RetCam wide-field infant fundus image; camera: Natus RetCam Envision (130° FOV)
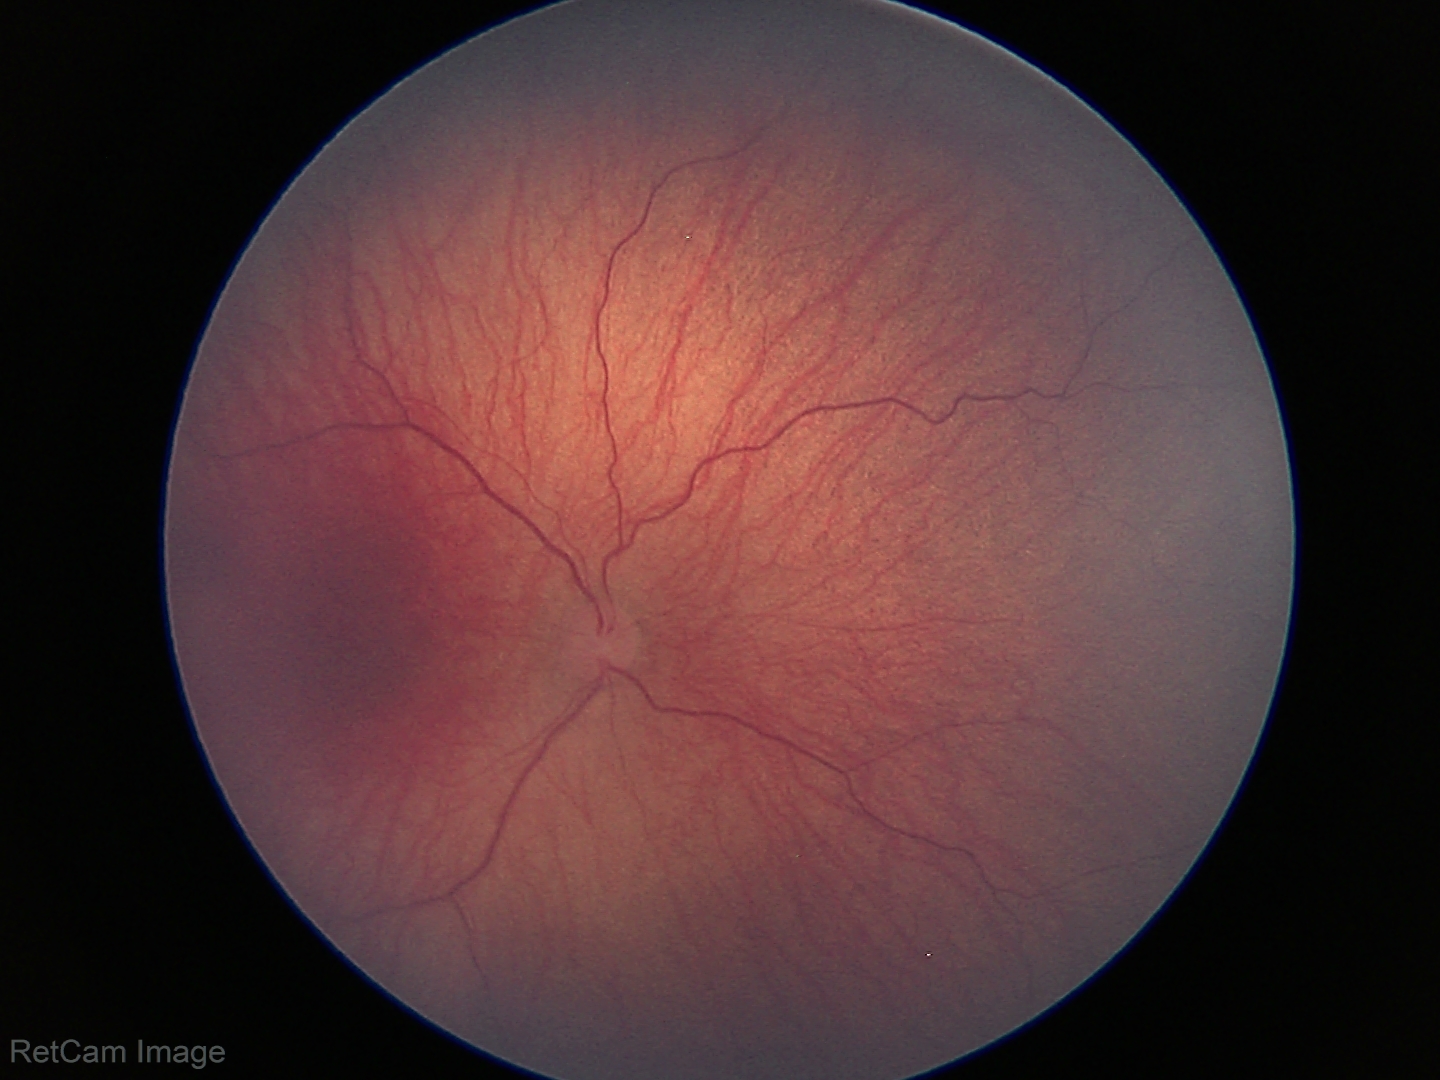
No plus disease.
Diagnosis from this screening exam: retinopathy of prematurity (ROP) stage 1 — demarcation line between vascular and avascular retina.